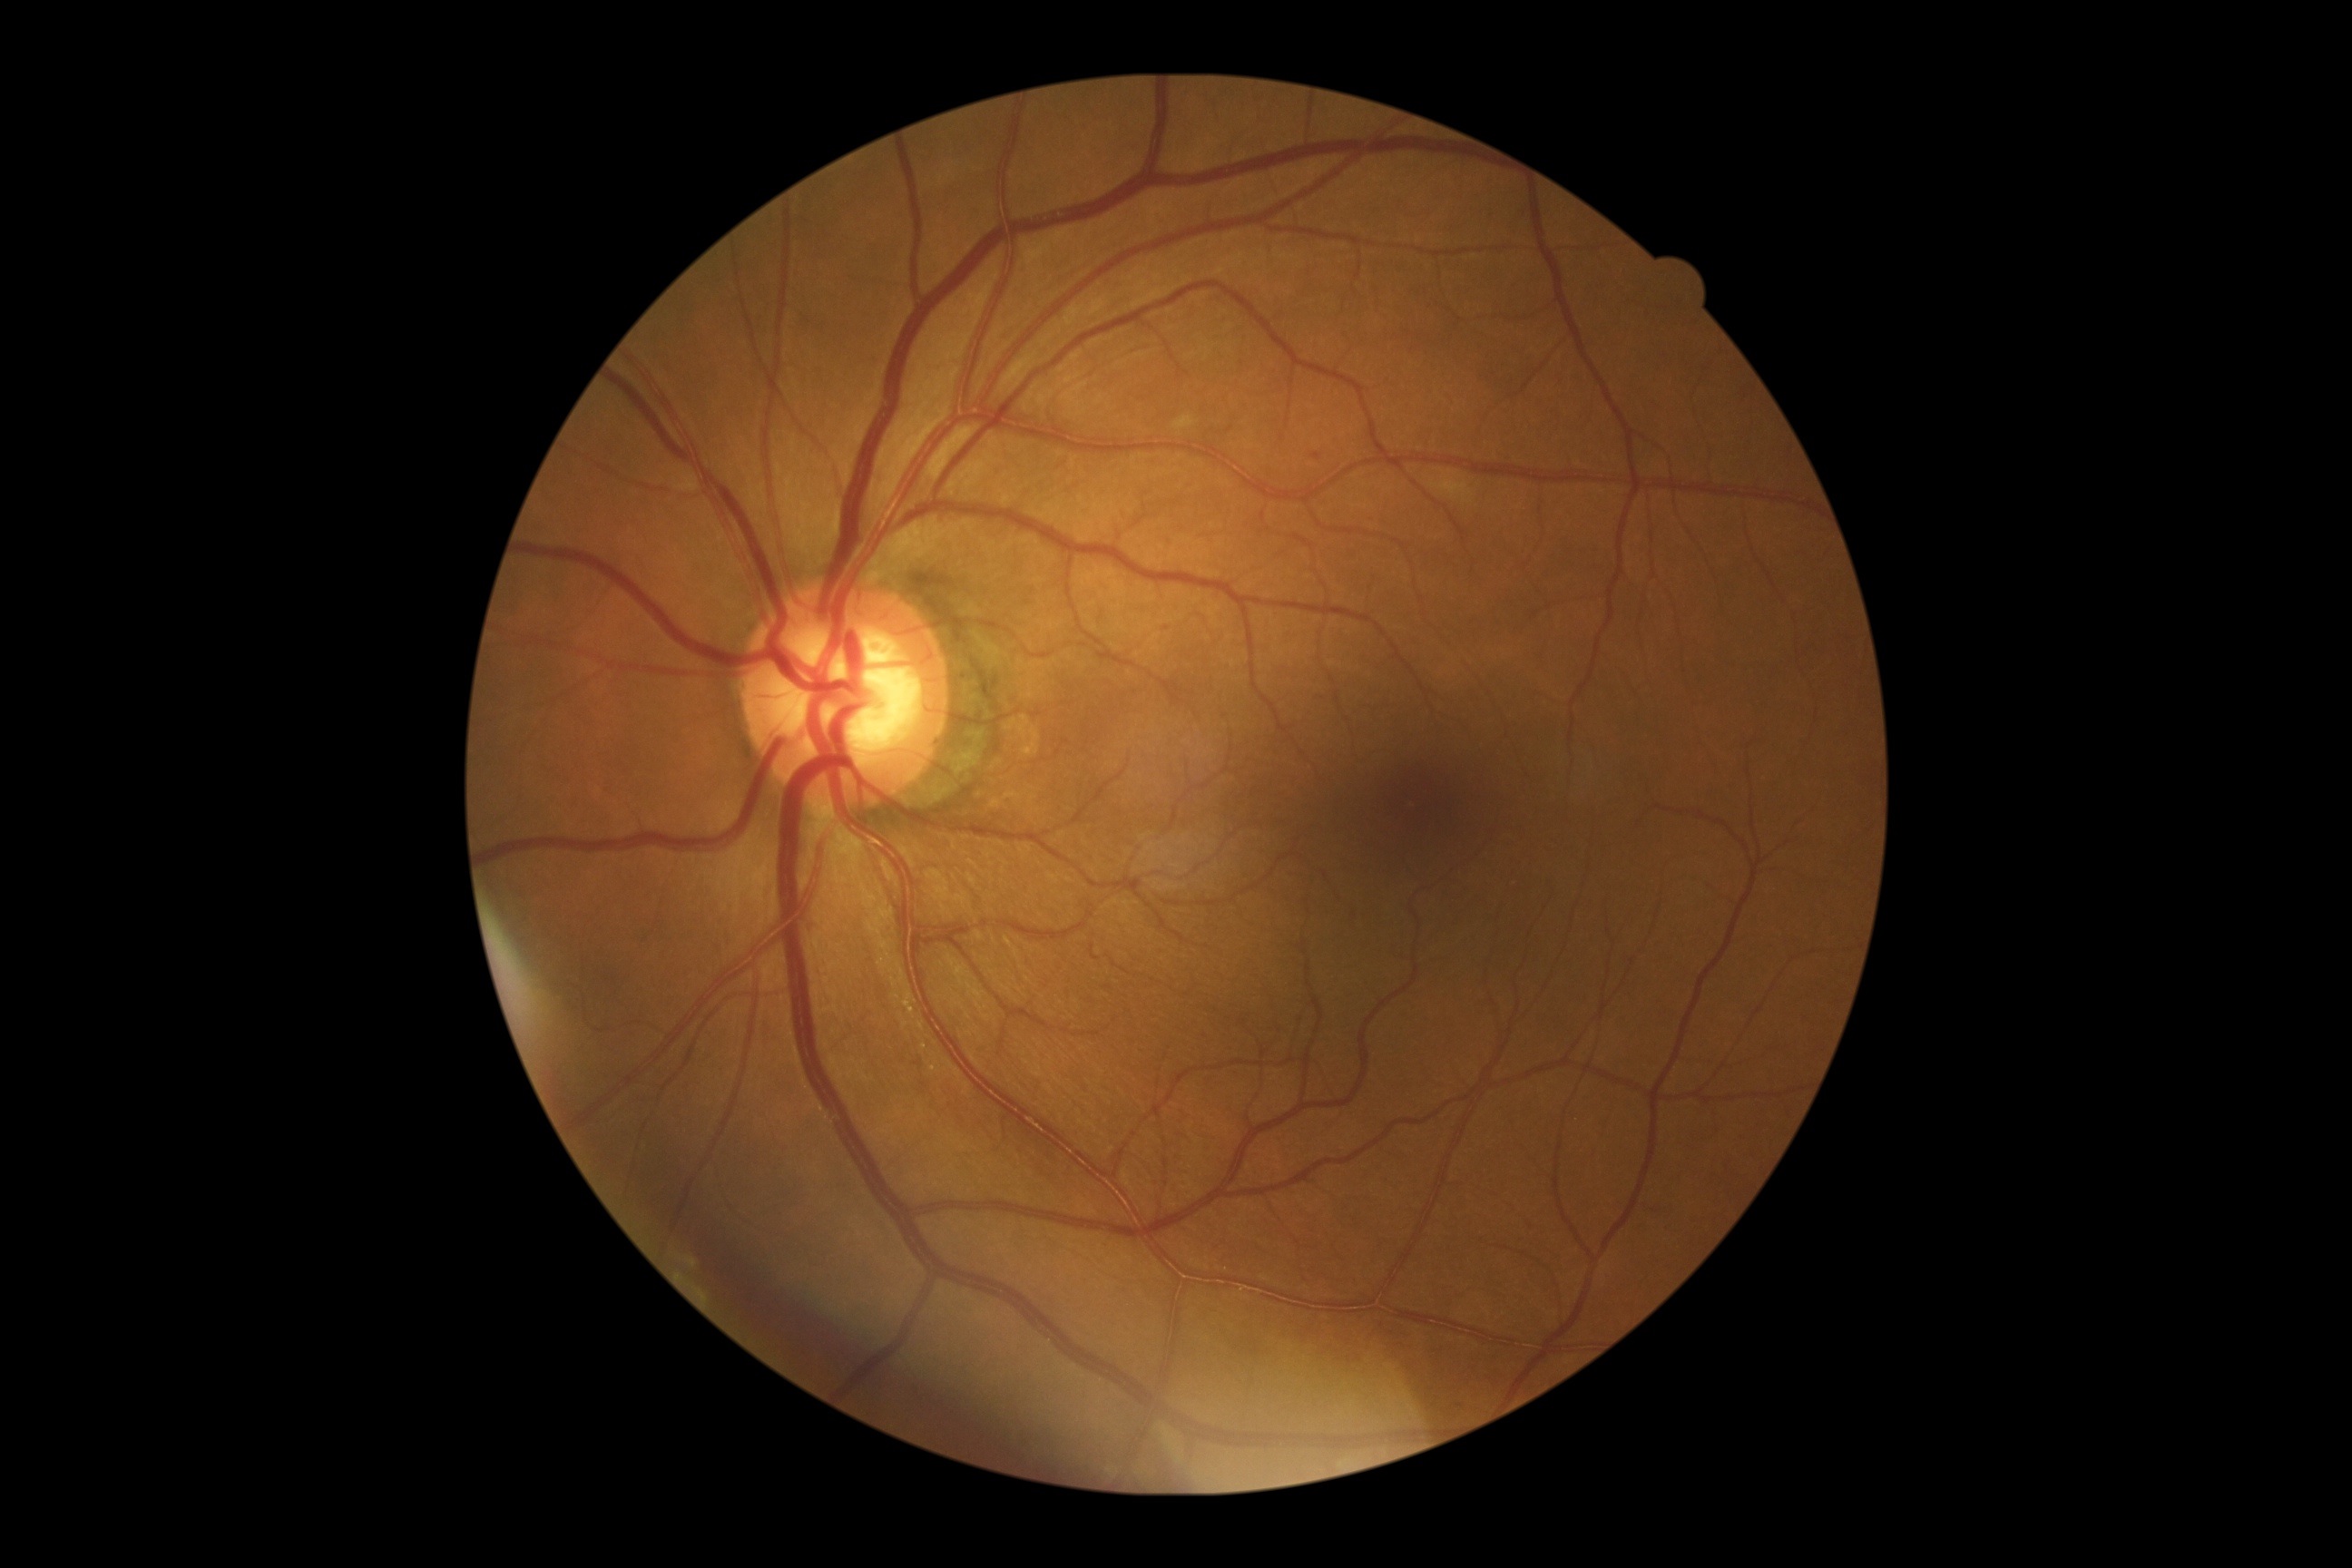
The retinopathy is classified as non-proliferative diabetic retinopathy. Diabetic retinopathy (DR): grade 2 (moderate NPDR).